50-degree field of view · acquired with a Topcon TRC-50DX — 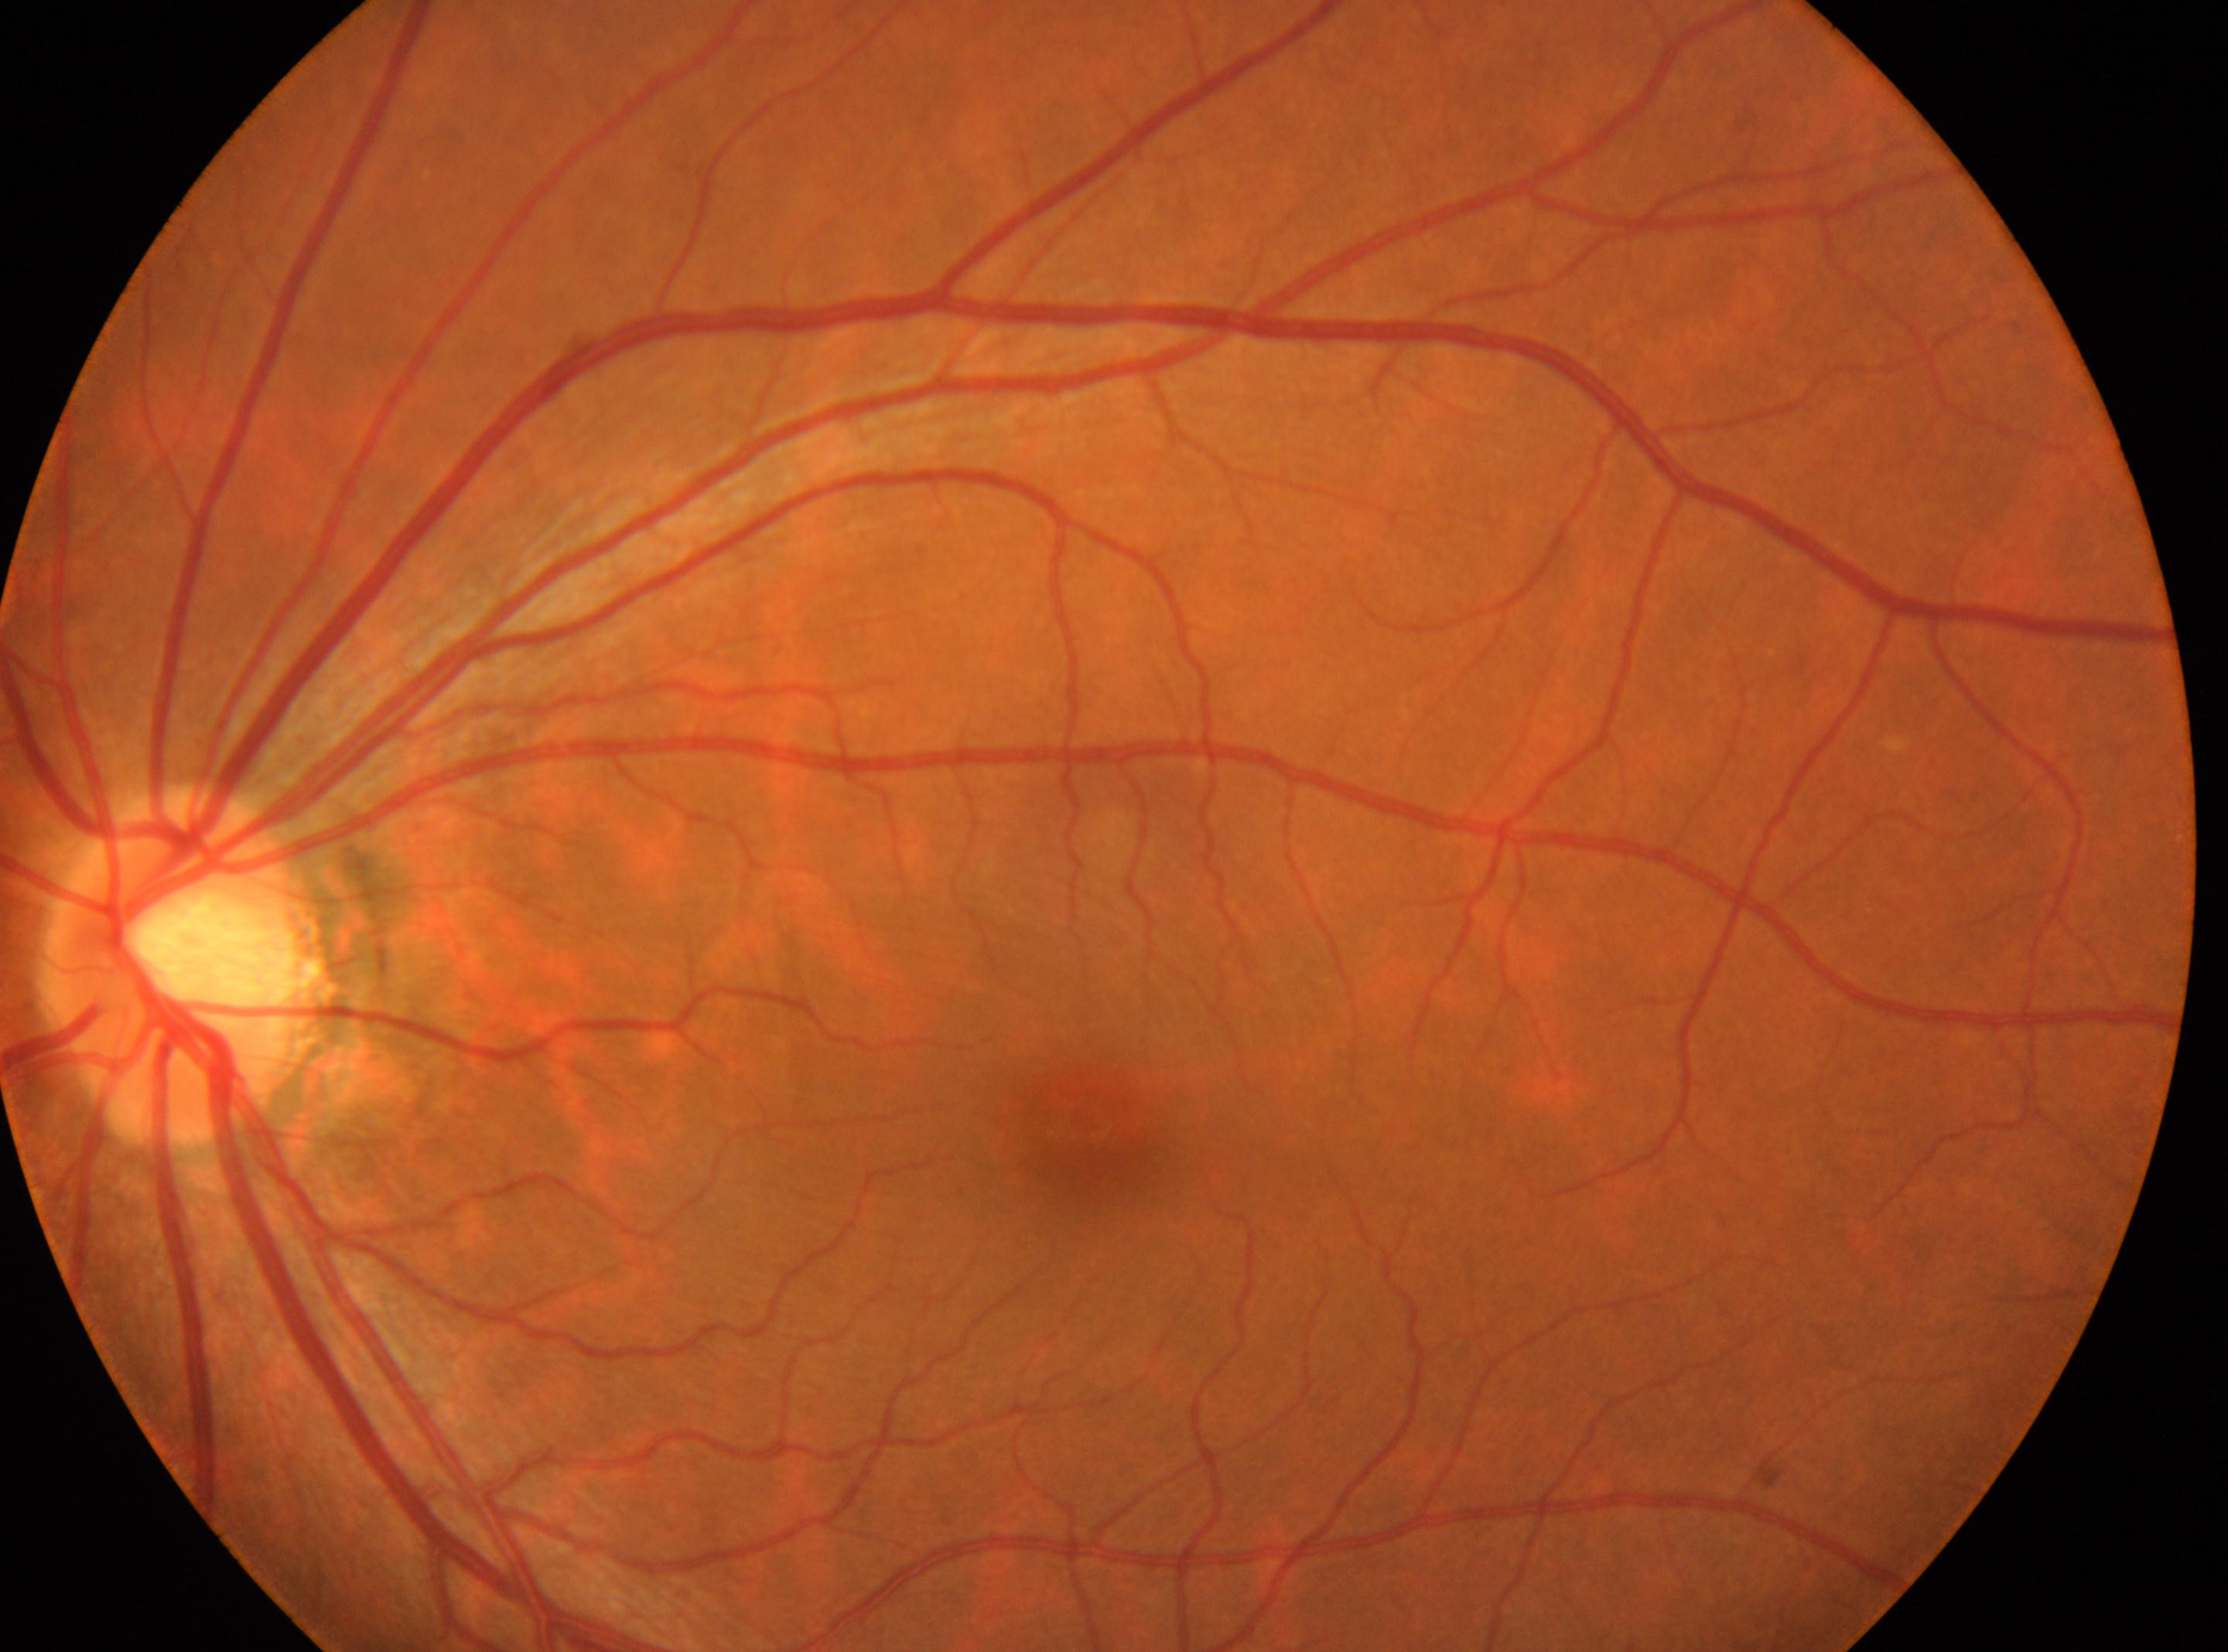
DR is no apparent retinopathy (grade 0).
Disc center located at [186, 962].
The macular center is at [1095, 1125].
The image shows the left eye.
No diabetic retinal disease findings.